45-degree field of view; image size 848x848; no pharmacologic dilation; posterior pole photograph — 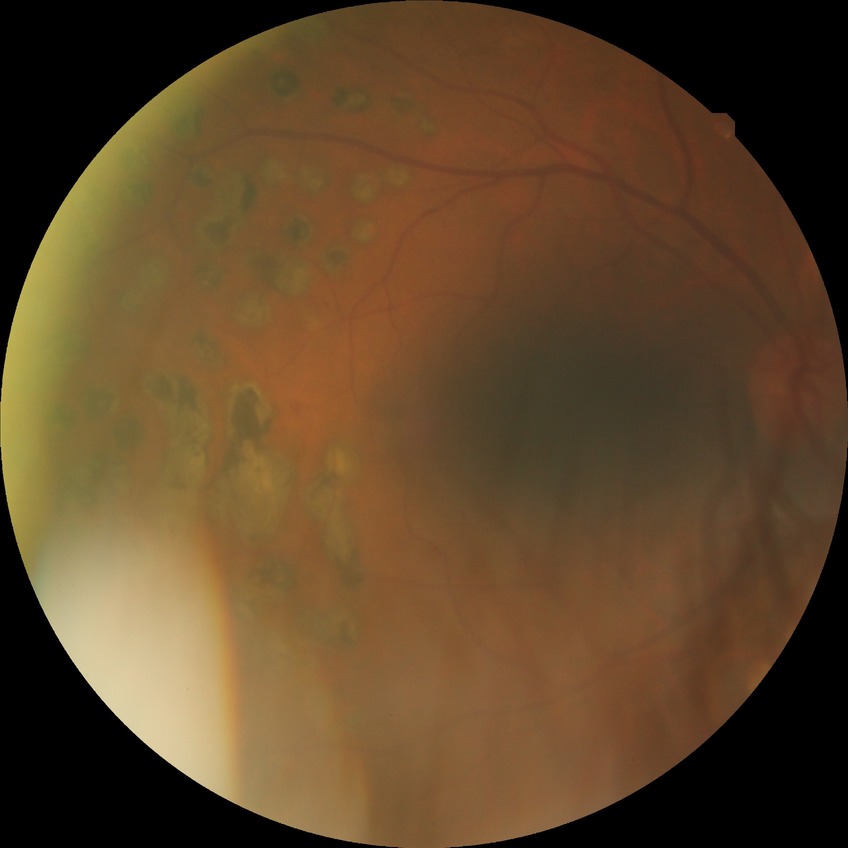

modified Davis classification=proliferative diabetic retinopathy.